Wide-field fundus photograph of an infant
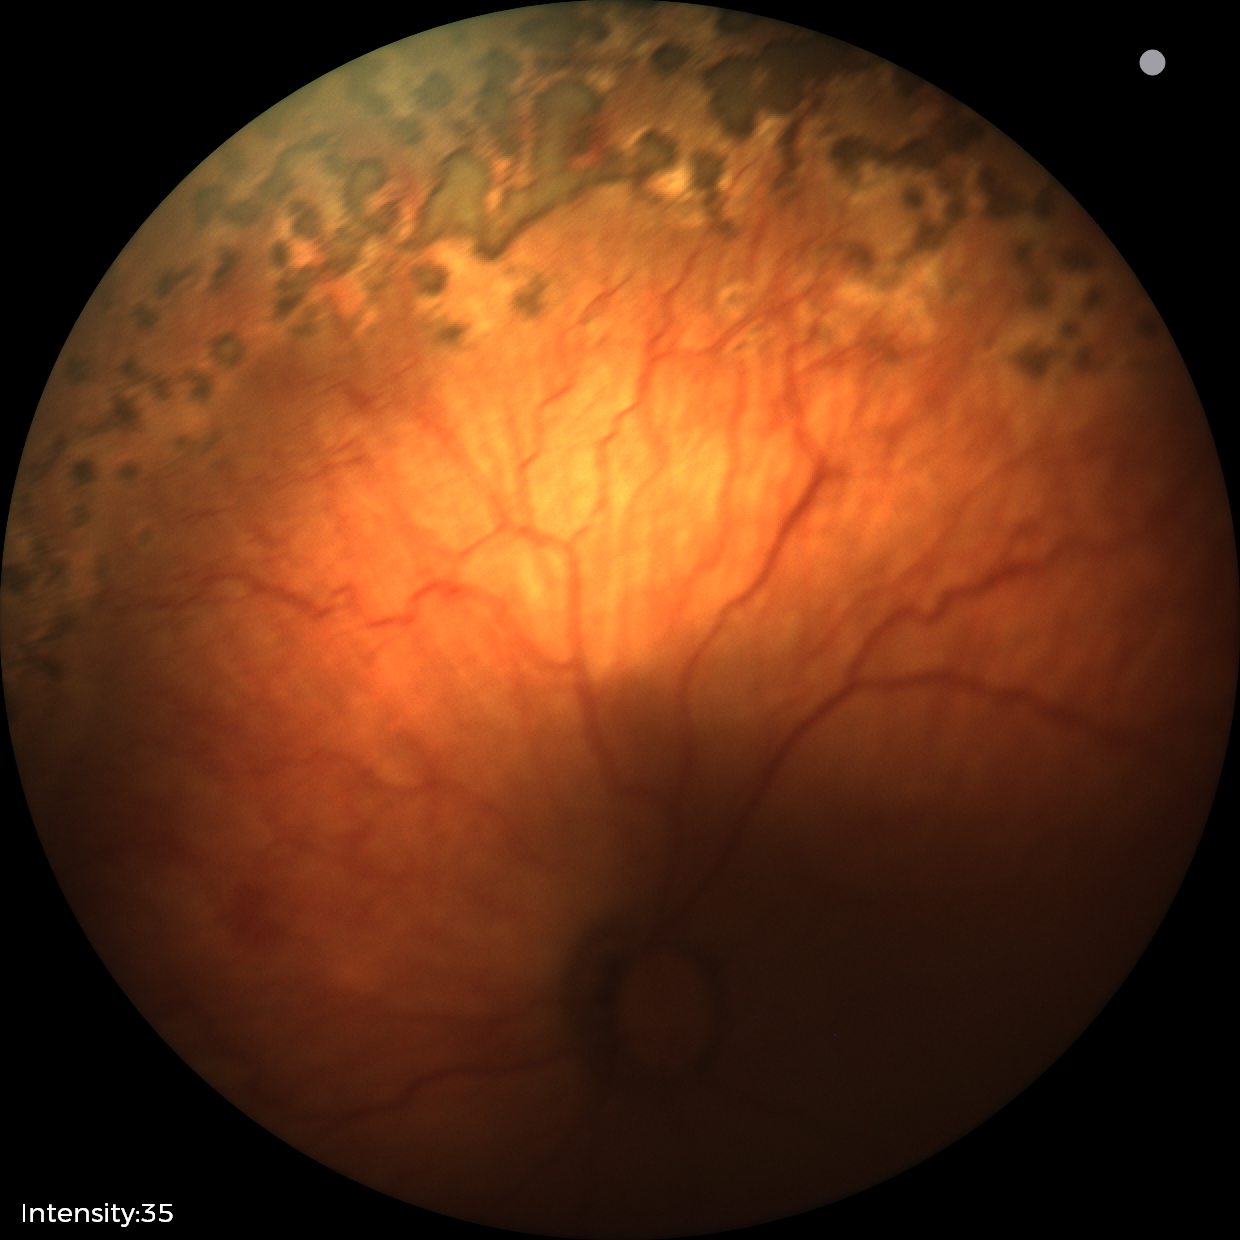
With plus disease. Screening series with ROP stage 1.